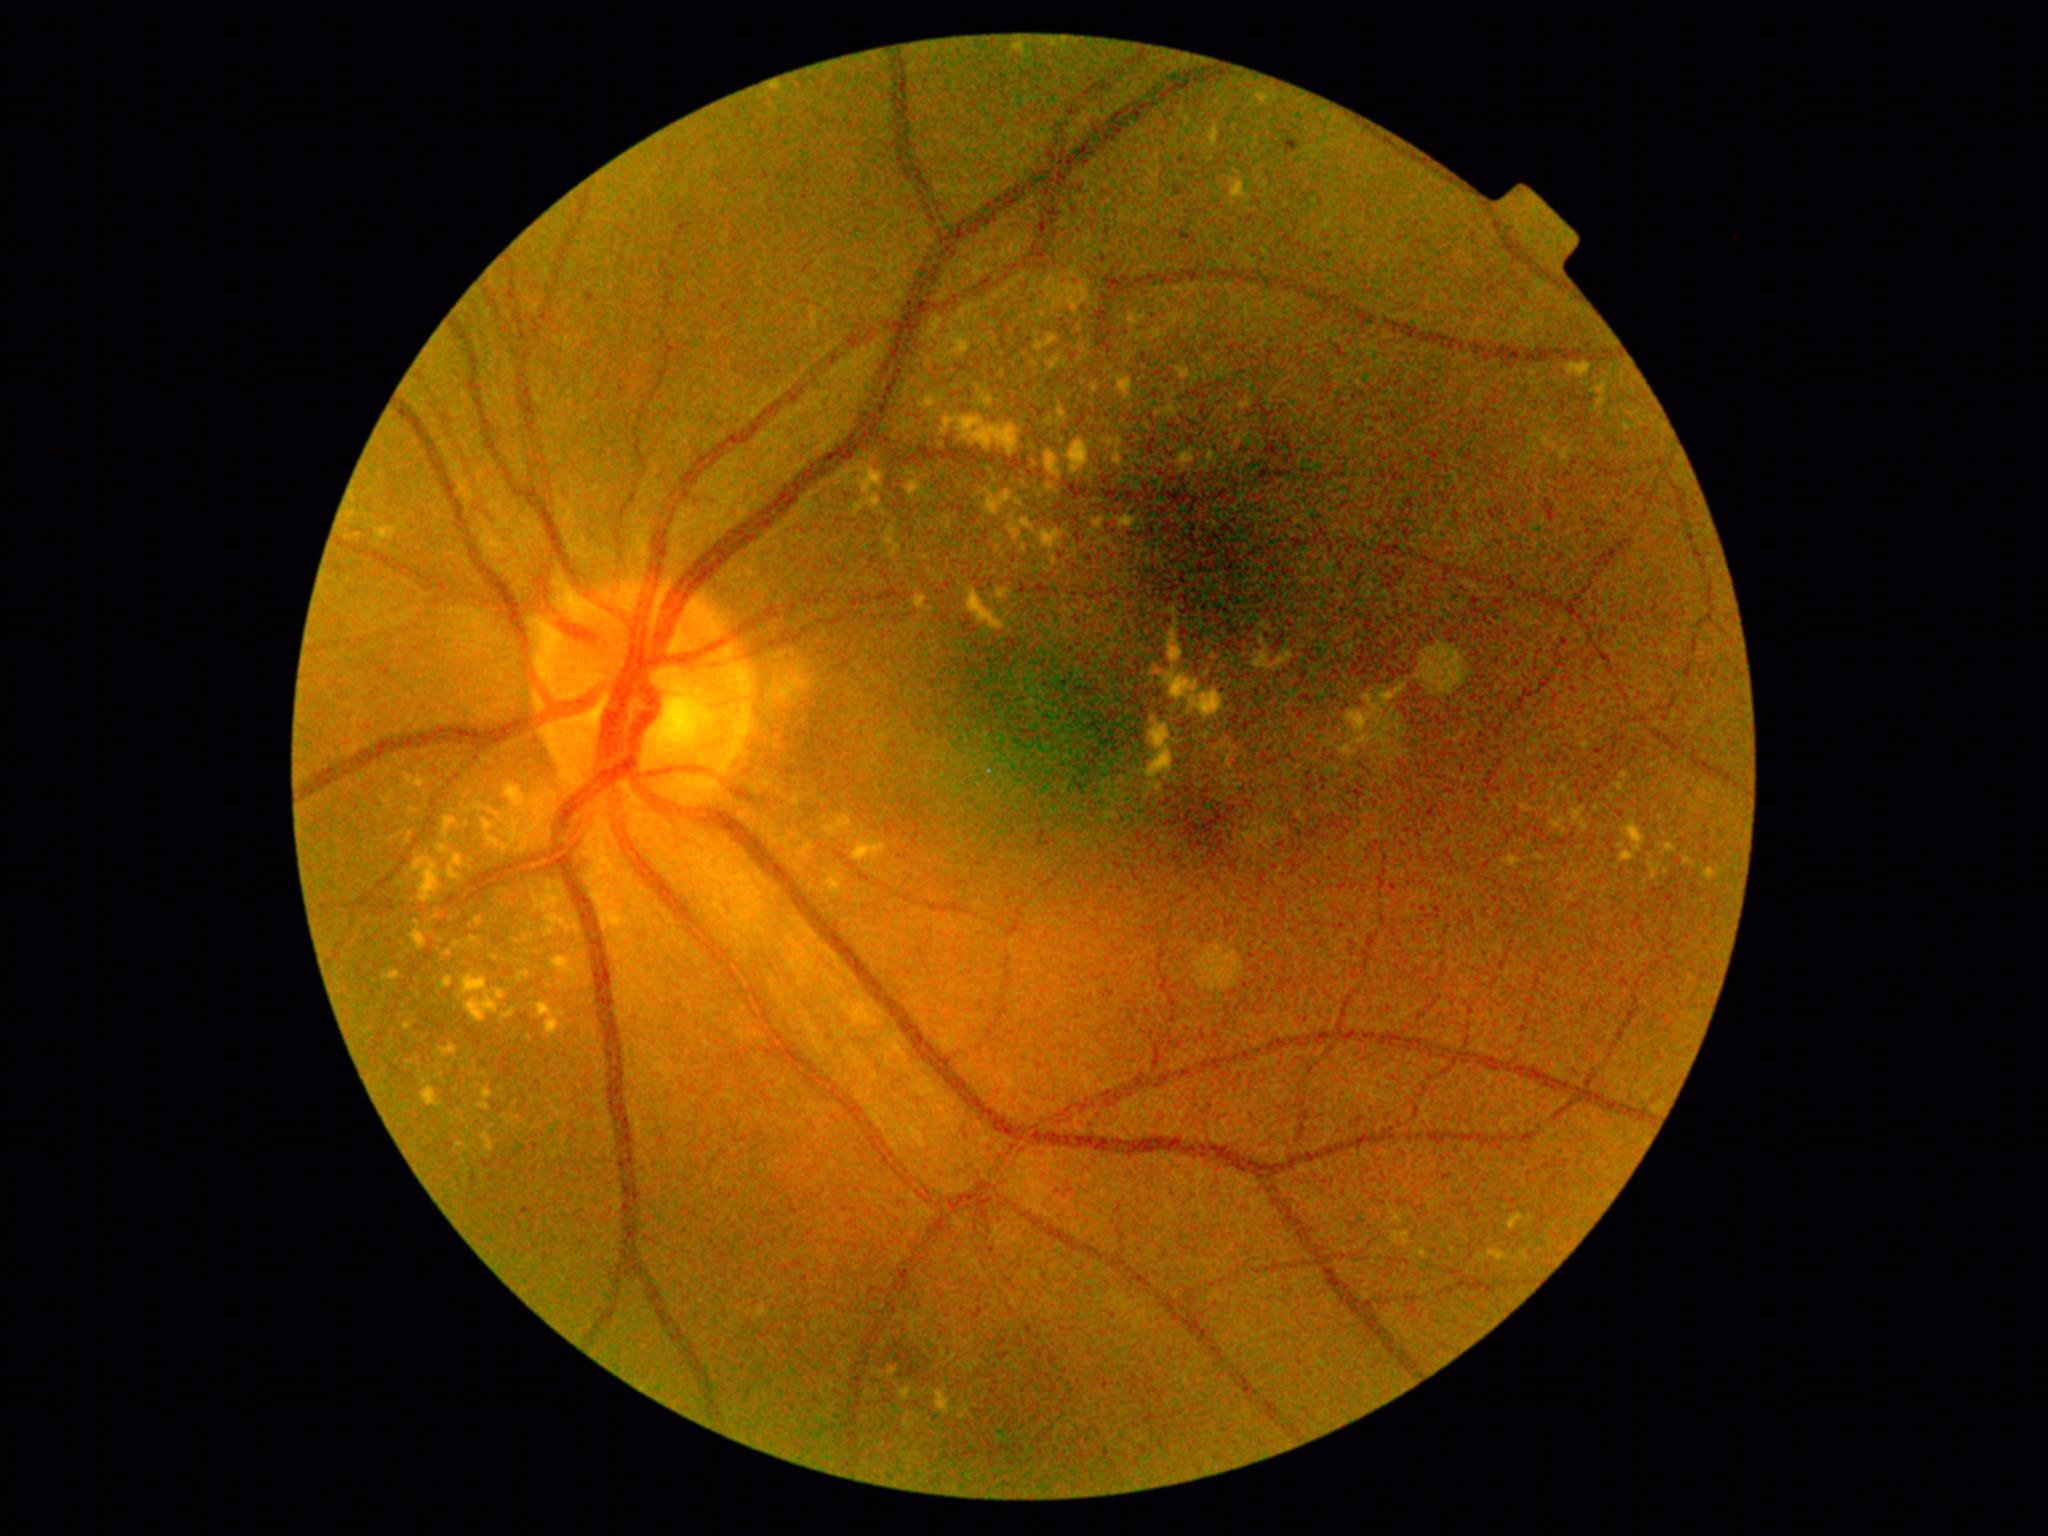

DR is moderate NPDR (grade 2).
EXs include lesions at l=449, t=868, r=459, b=880 | l=1261, t=636, r=1265, b=644 | l=1567, t=364, r=1592, b=377 | l=1092, t=520, r=1102, b=527 | l=1616, t=783, r=1626, b=794 | l=484, t=821, r=493, b=831 | l=547, t=917, r=566, b=928 | l=1191, t=690, r=1222, b=718 | l=911, t=596, r=927, b=607 | l=1258, t=95, r=1268, b=103 | l=959, t=341, r=967, b=348 | l=1628, t=825, r=1645, b=852.
Small EXs approximately at Point(487, 1138) | Point(506, 849) | Point(808, 847) | Point(1115, 456) | Point(831, 831).